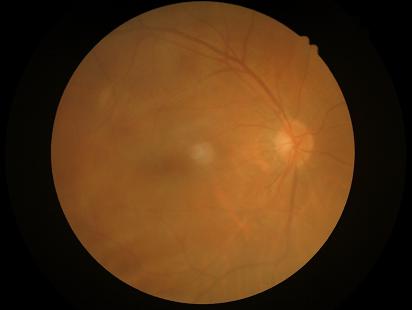

Reduced sharpness with visible blur. No over- or under-exposure. Vessels and details are readily distinguishable. Overall quality is poor; the image is difficult to grade.